Pediatric retinal photograph (wide-field):
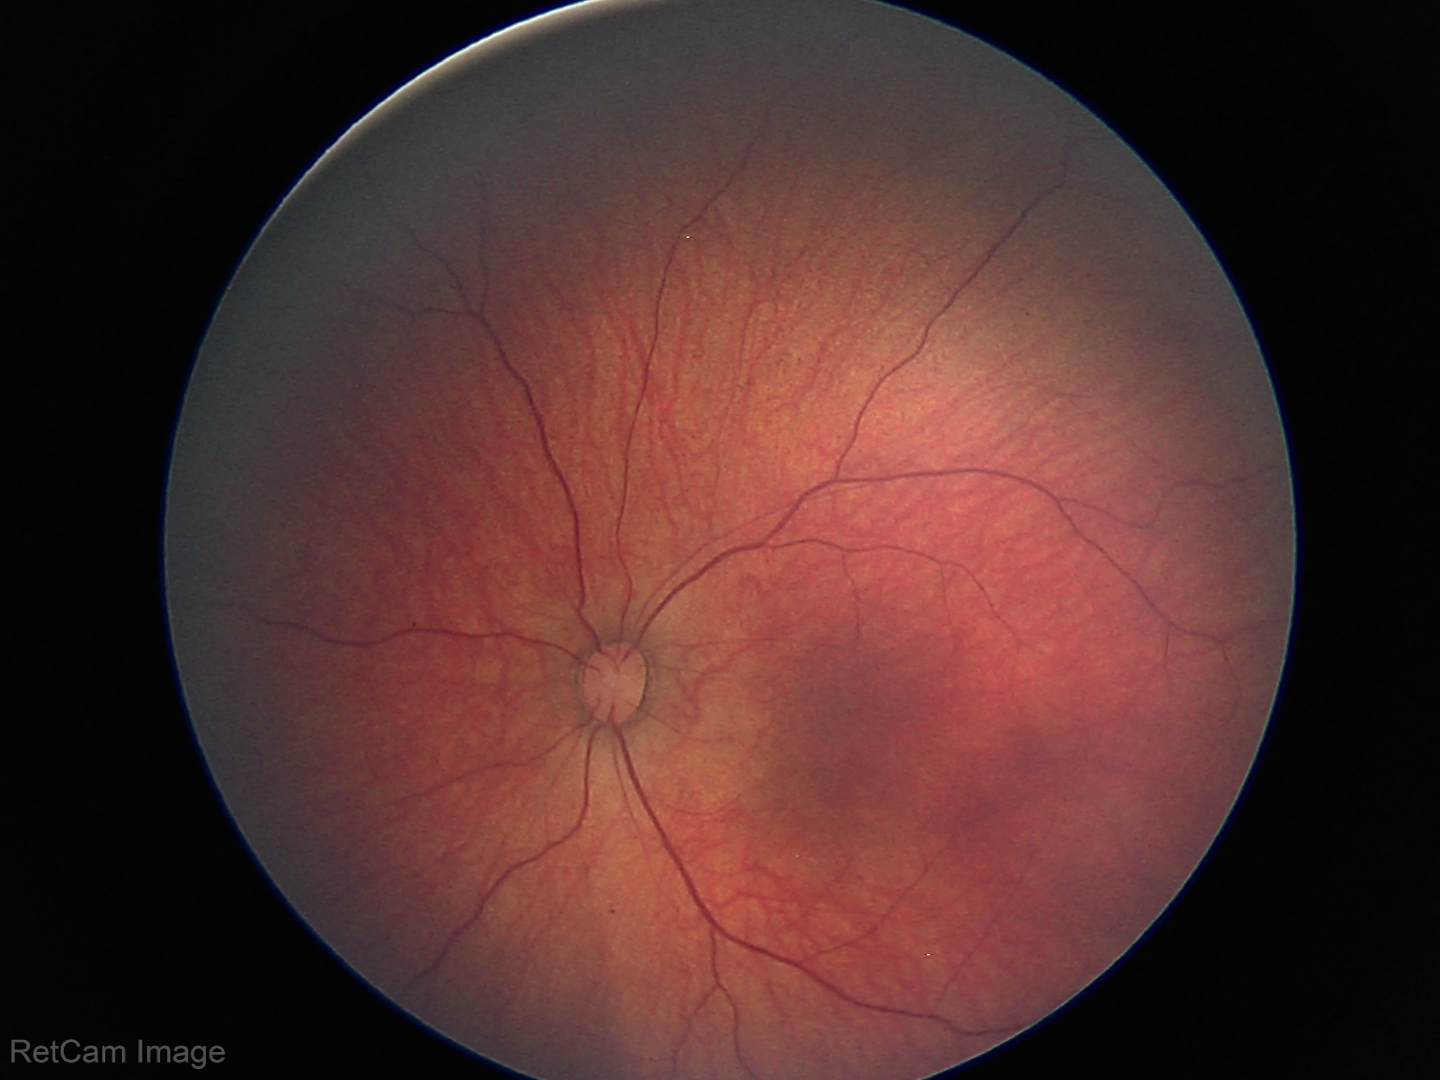 Screening: retinal hemorrhages.